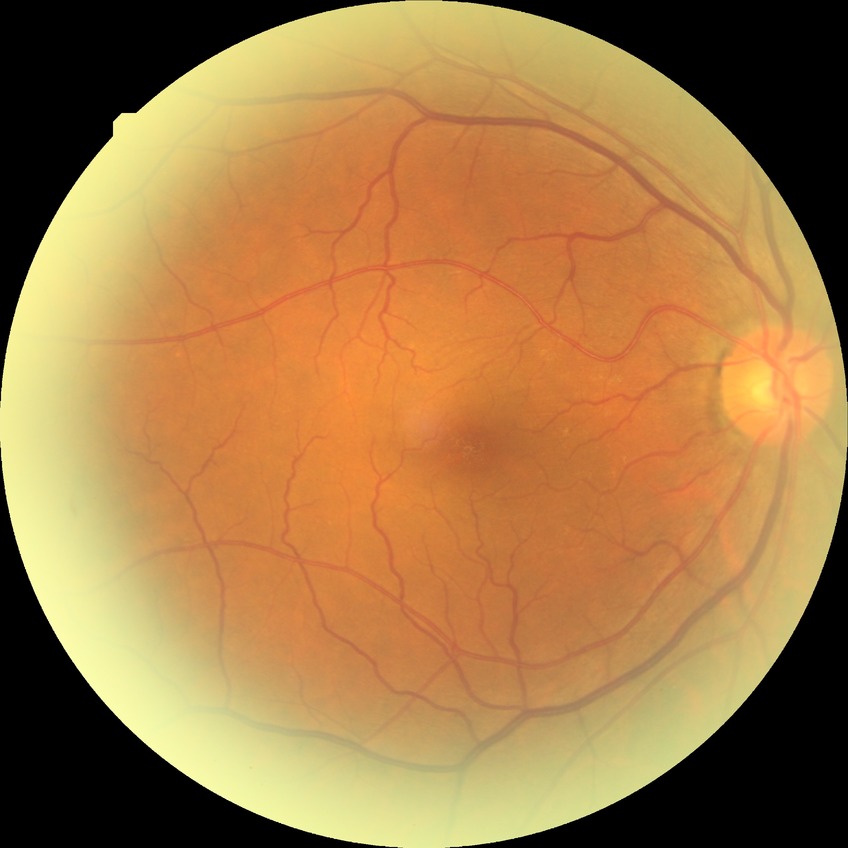

DR grade is NDR.